Portable fundus photograph — 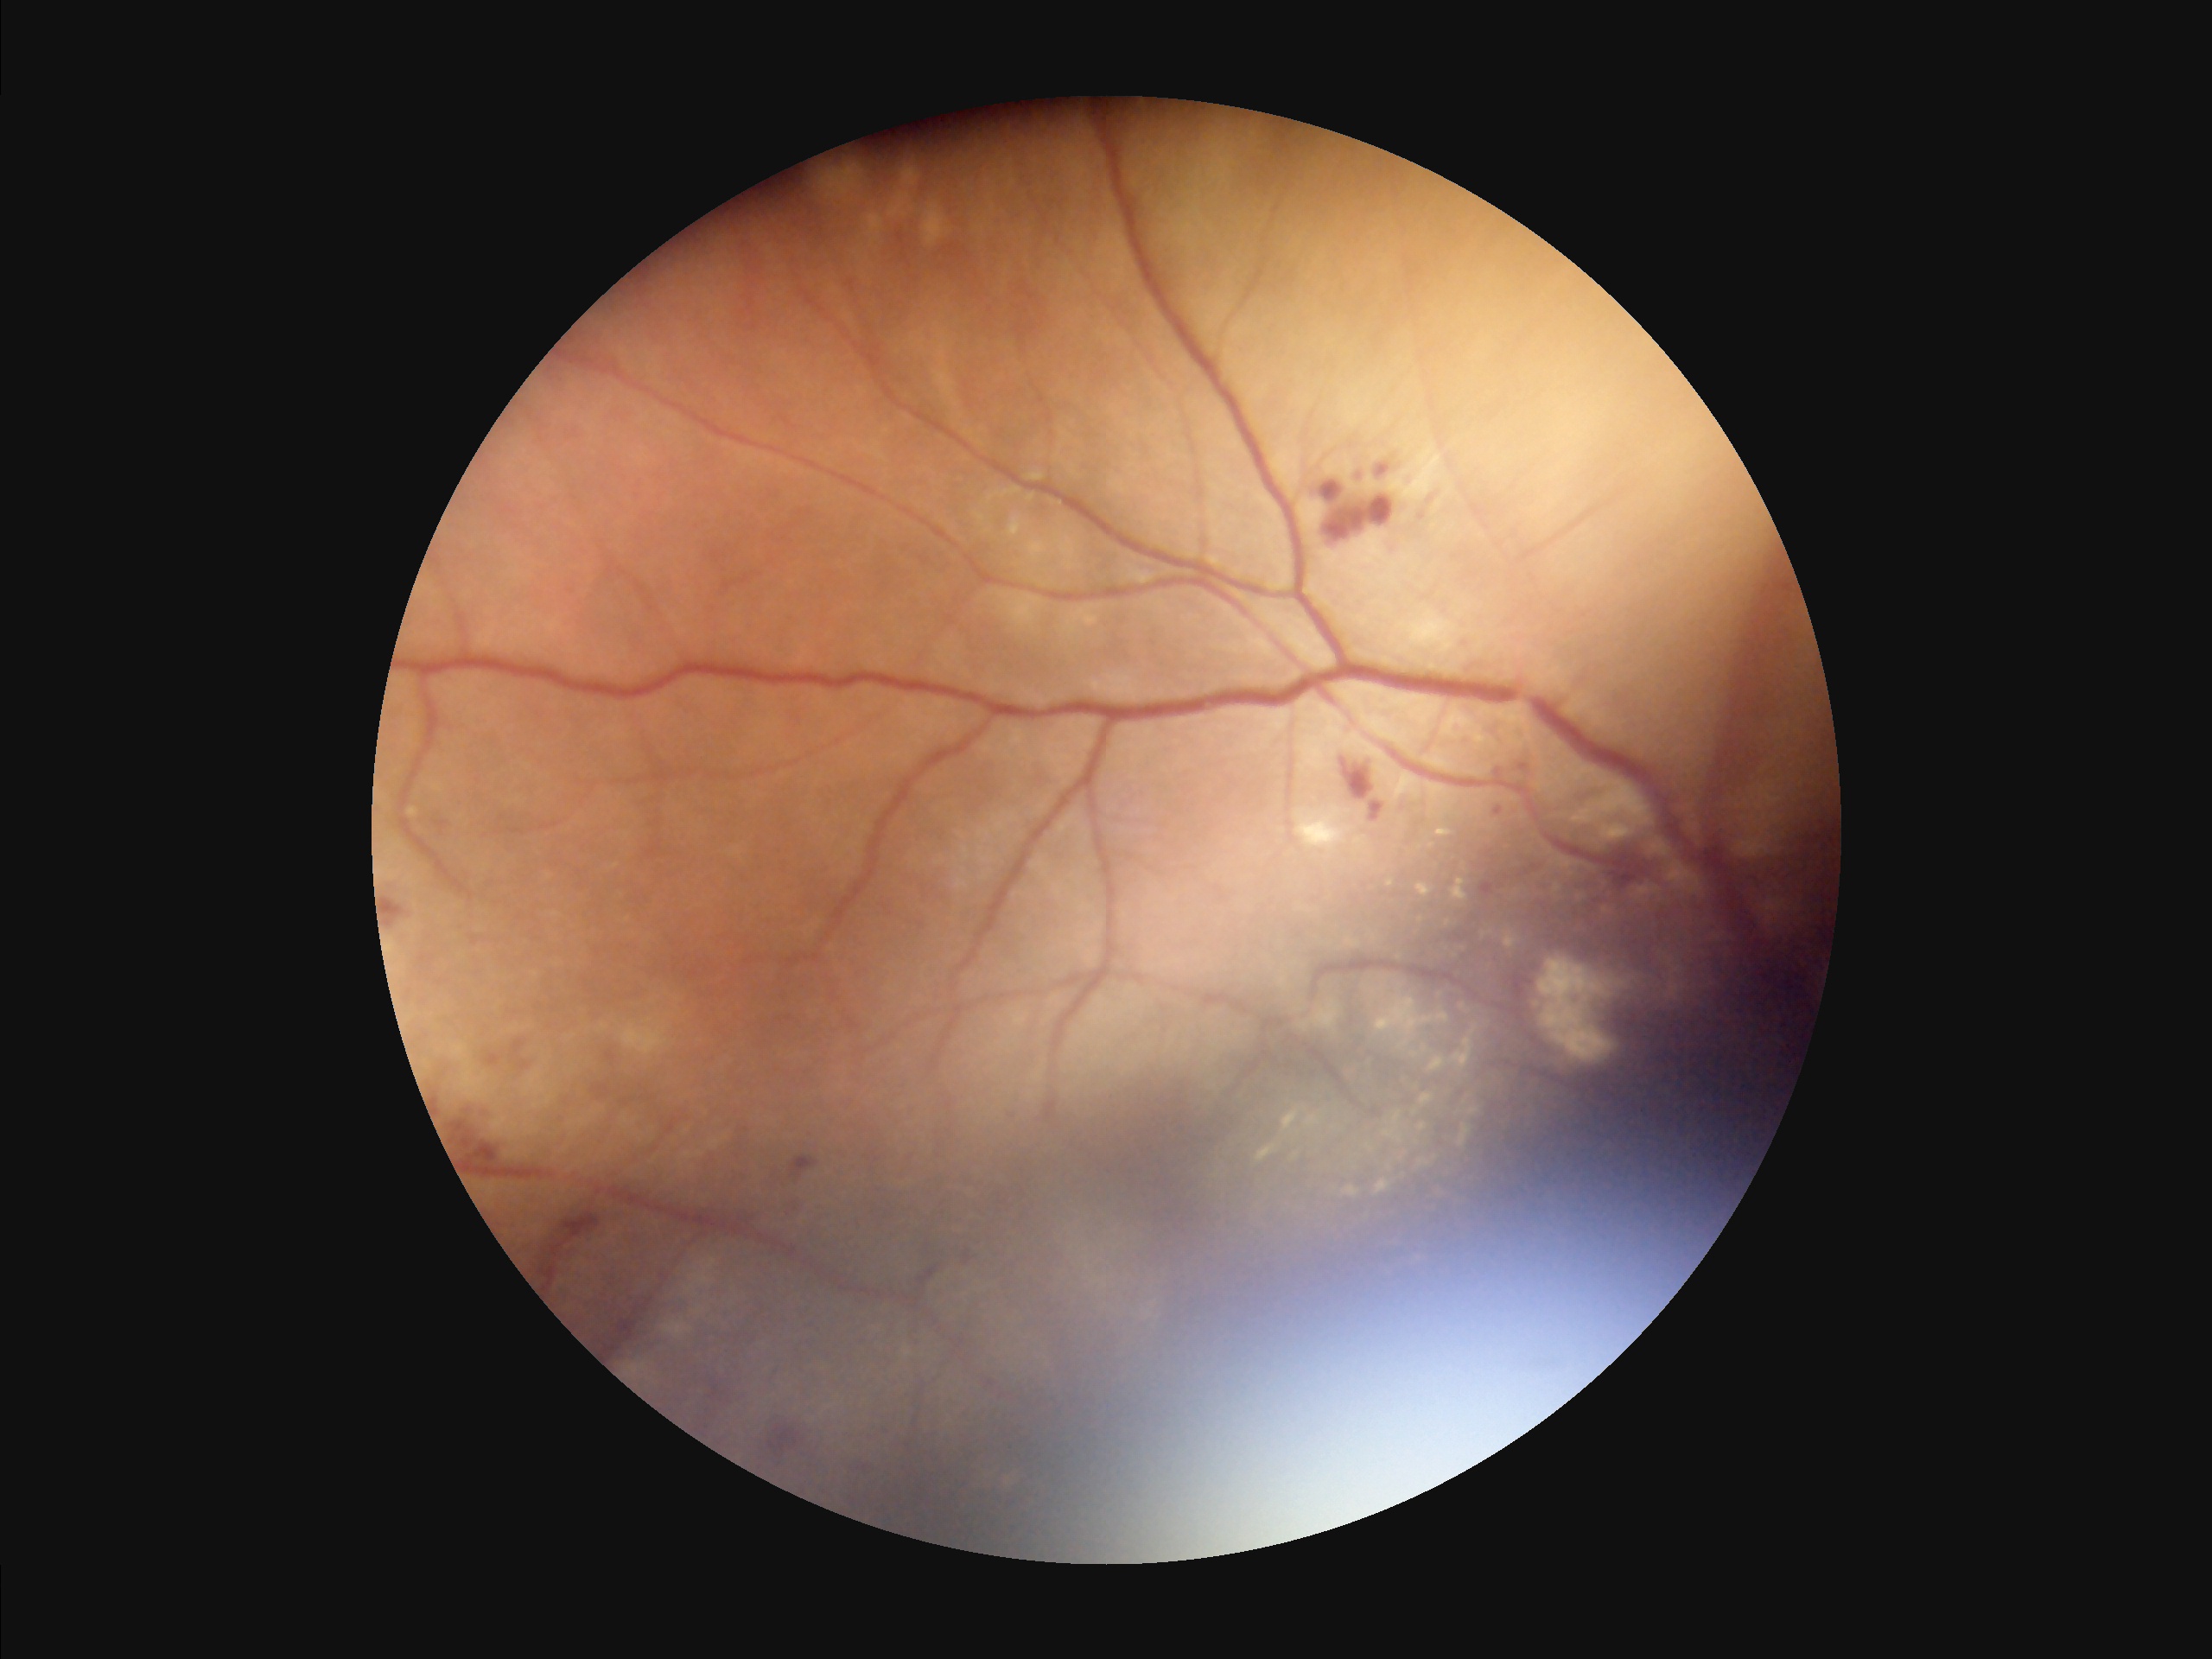
Clarity = blurry
Illumination = suboptimal
Overall quality = inadequate